Fundus photo — 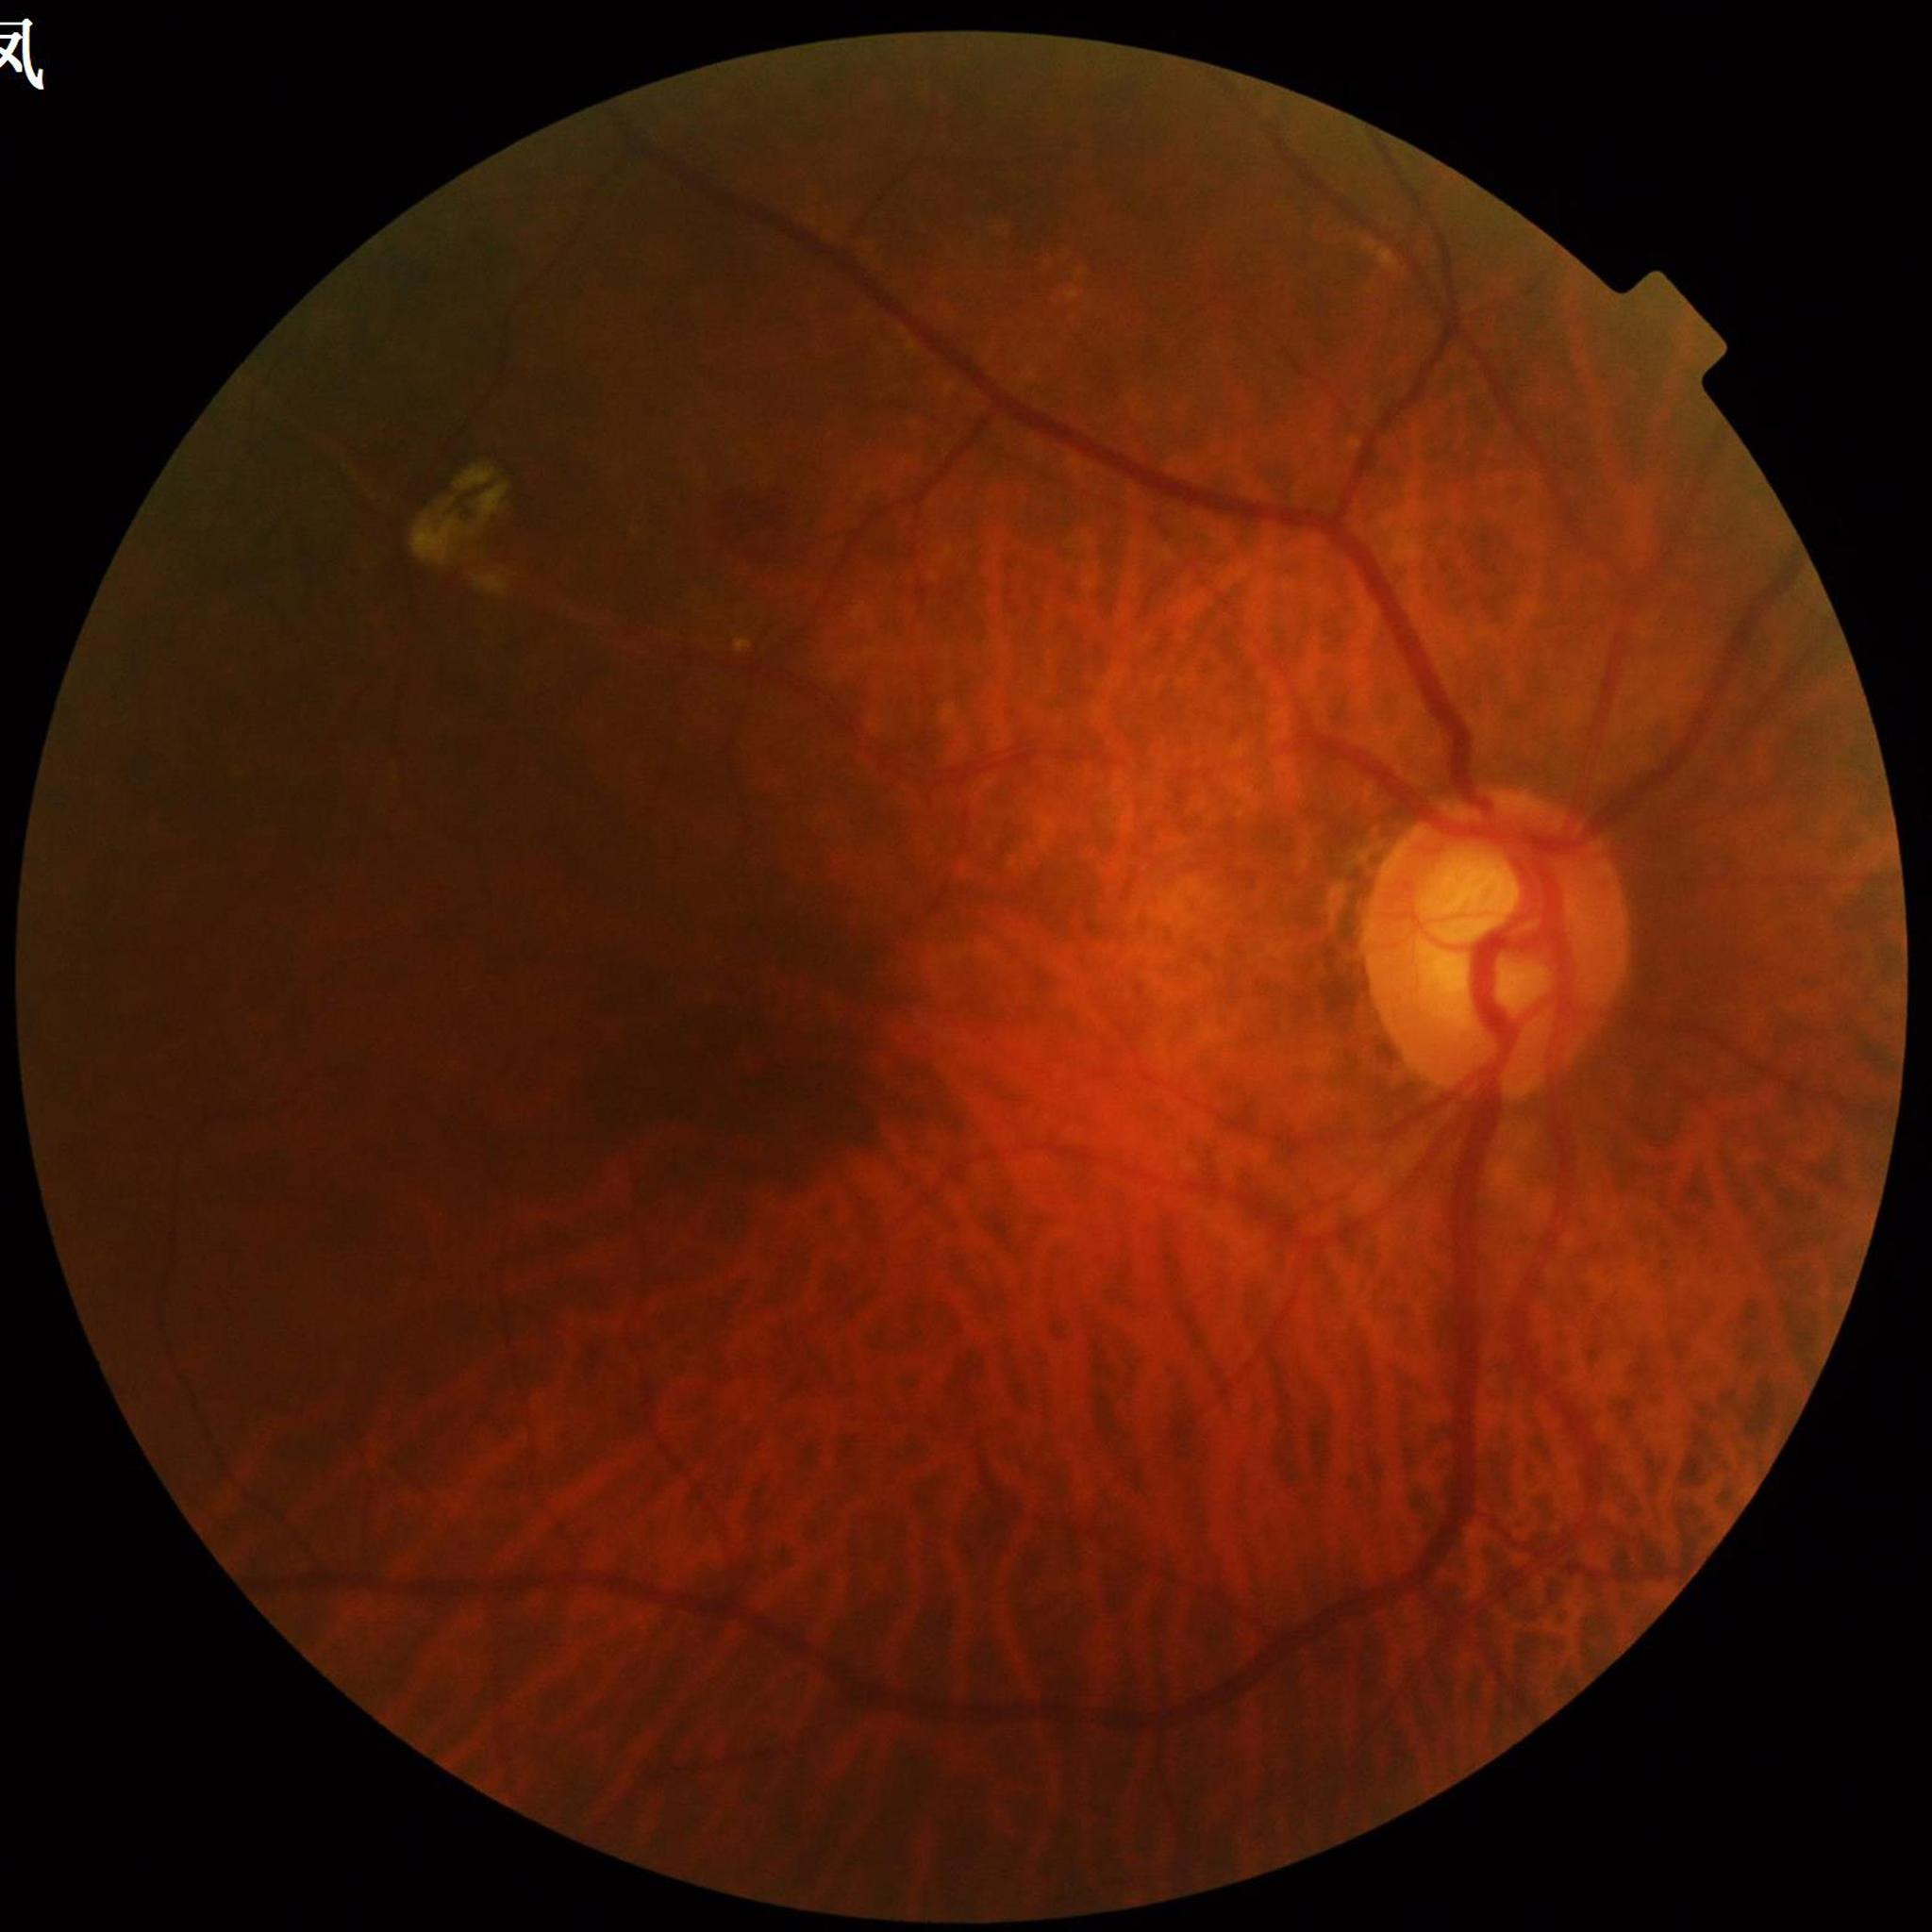 Quality assessment: no blur, contrast adequate, illumination and color satisfactory. Diagnosed with diabetic retinopathy.